Wide-field fundus photograph from neonatal ROP screening; image size 640x480
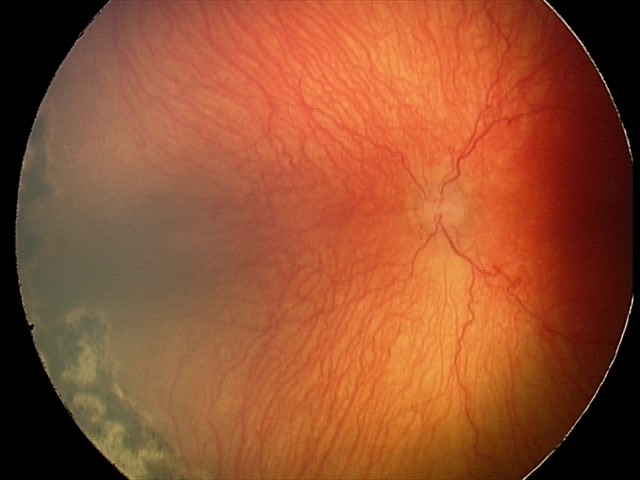 From an examination with diagnosis of A-ROP (aggressive ROP). Plus disease present.